Wide-field contact fundus photograph of an infant — 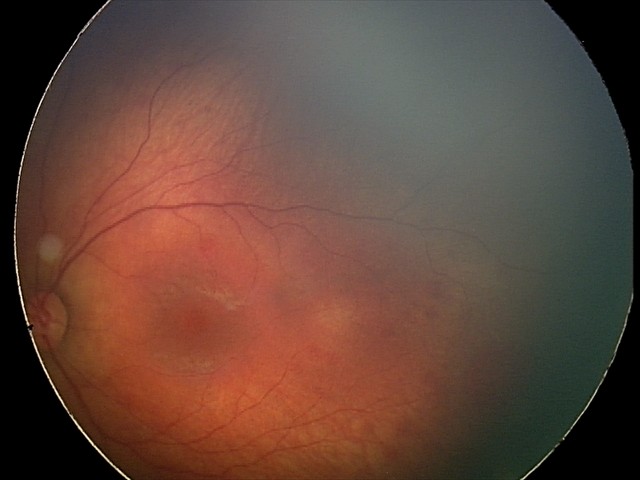
Screening examination consistent with retinal hemorrhages.